Acquired on the Phoenix ICON · wide-field fundus photograph of an infant.
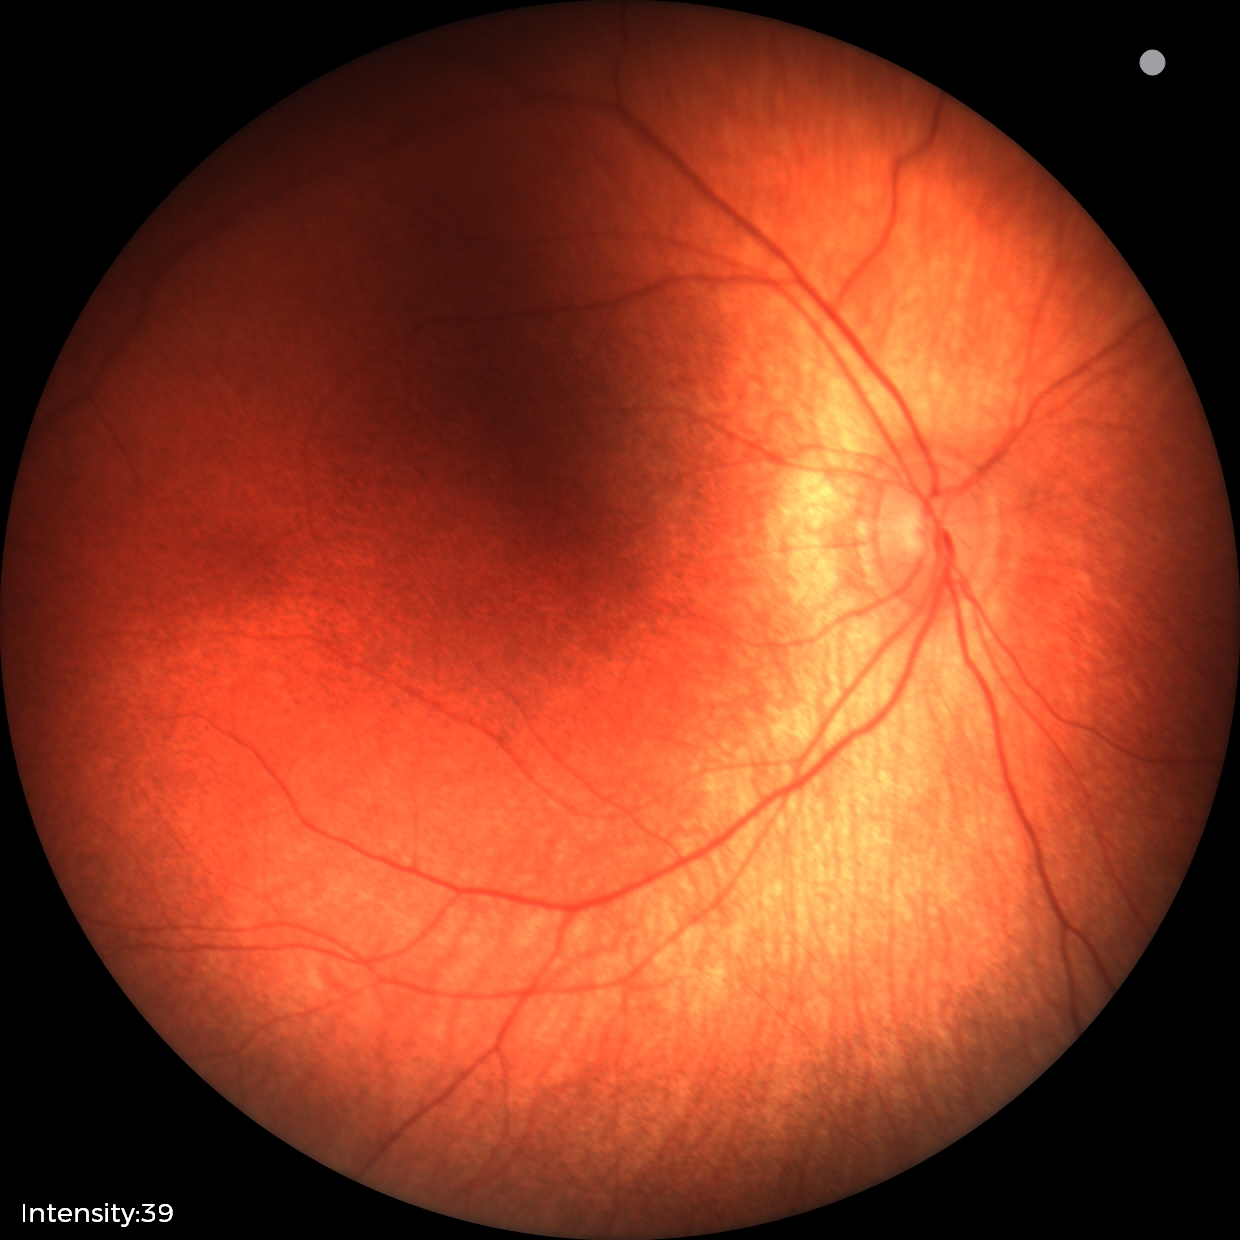

Examination with physiological retinal findings.